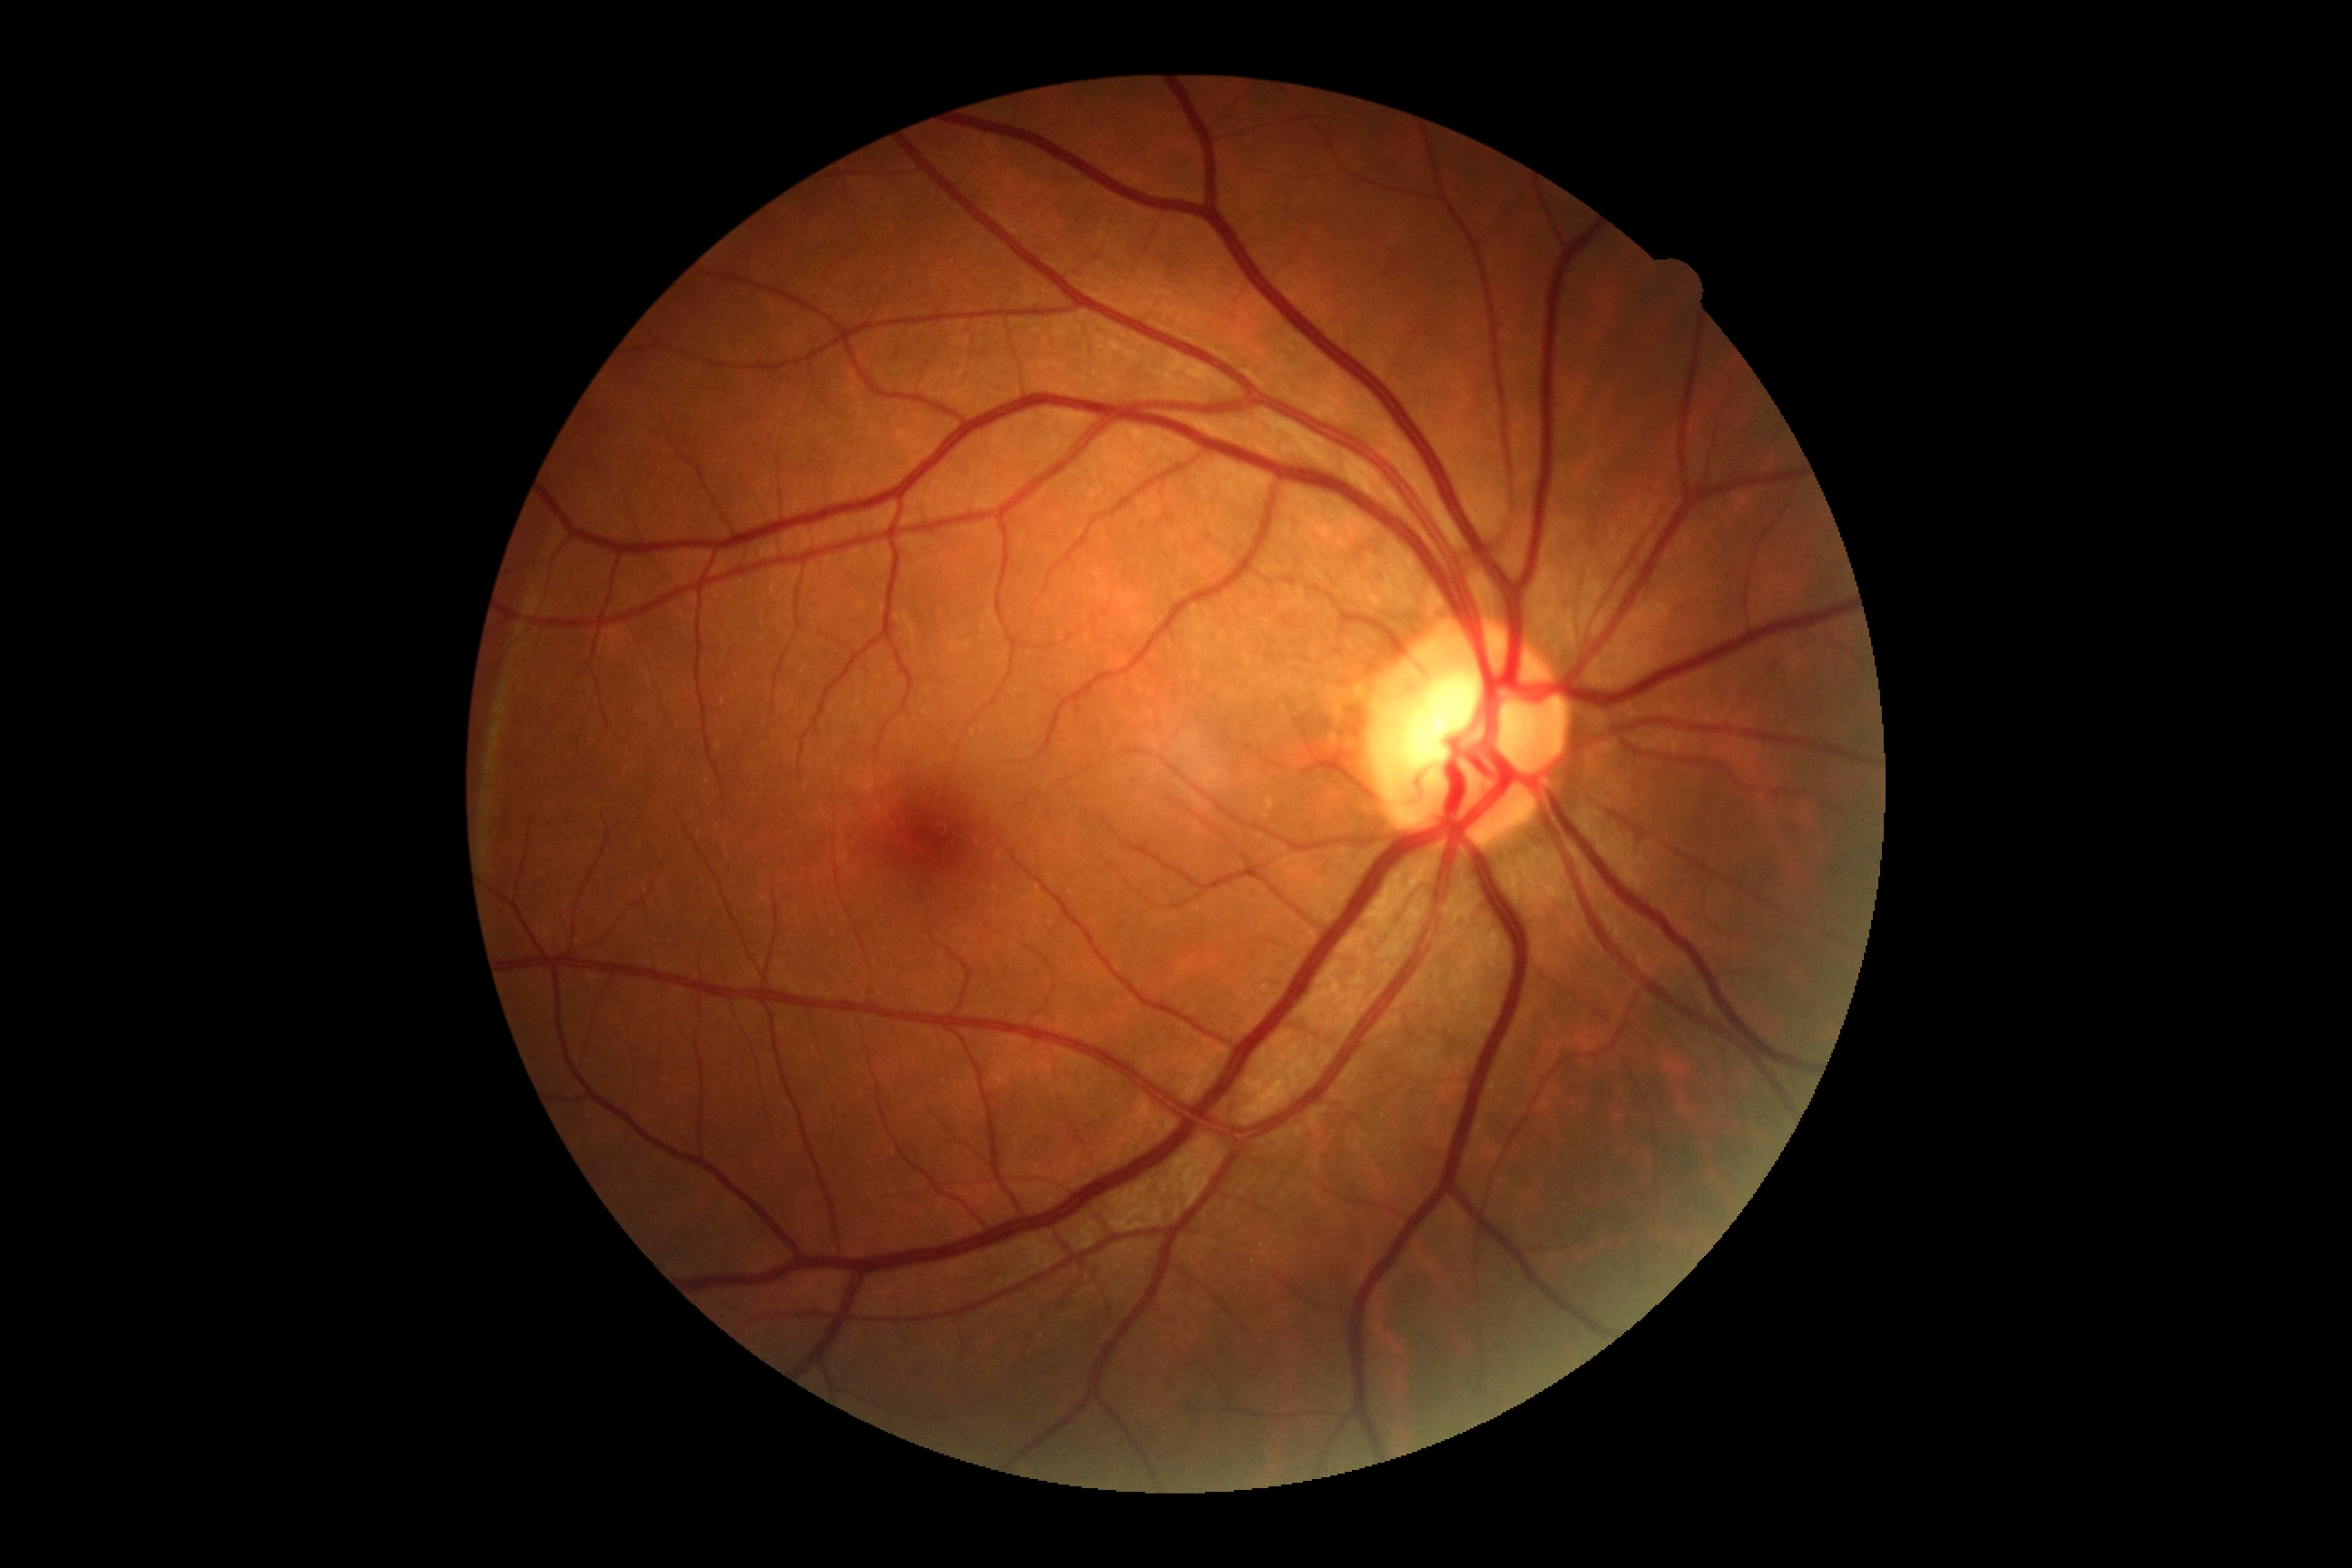
DR grade: 0.